Fundus photo. 2228 by 1652 pixels. 50° FOV. Field includes the optic disc and macula.
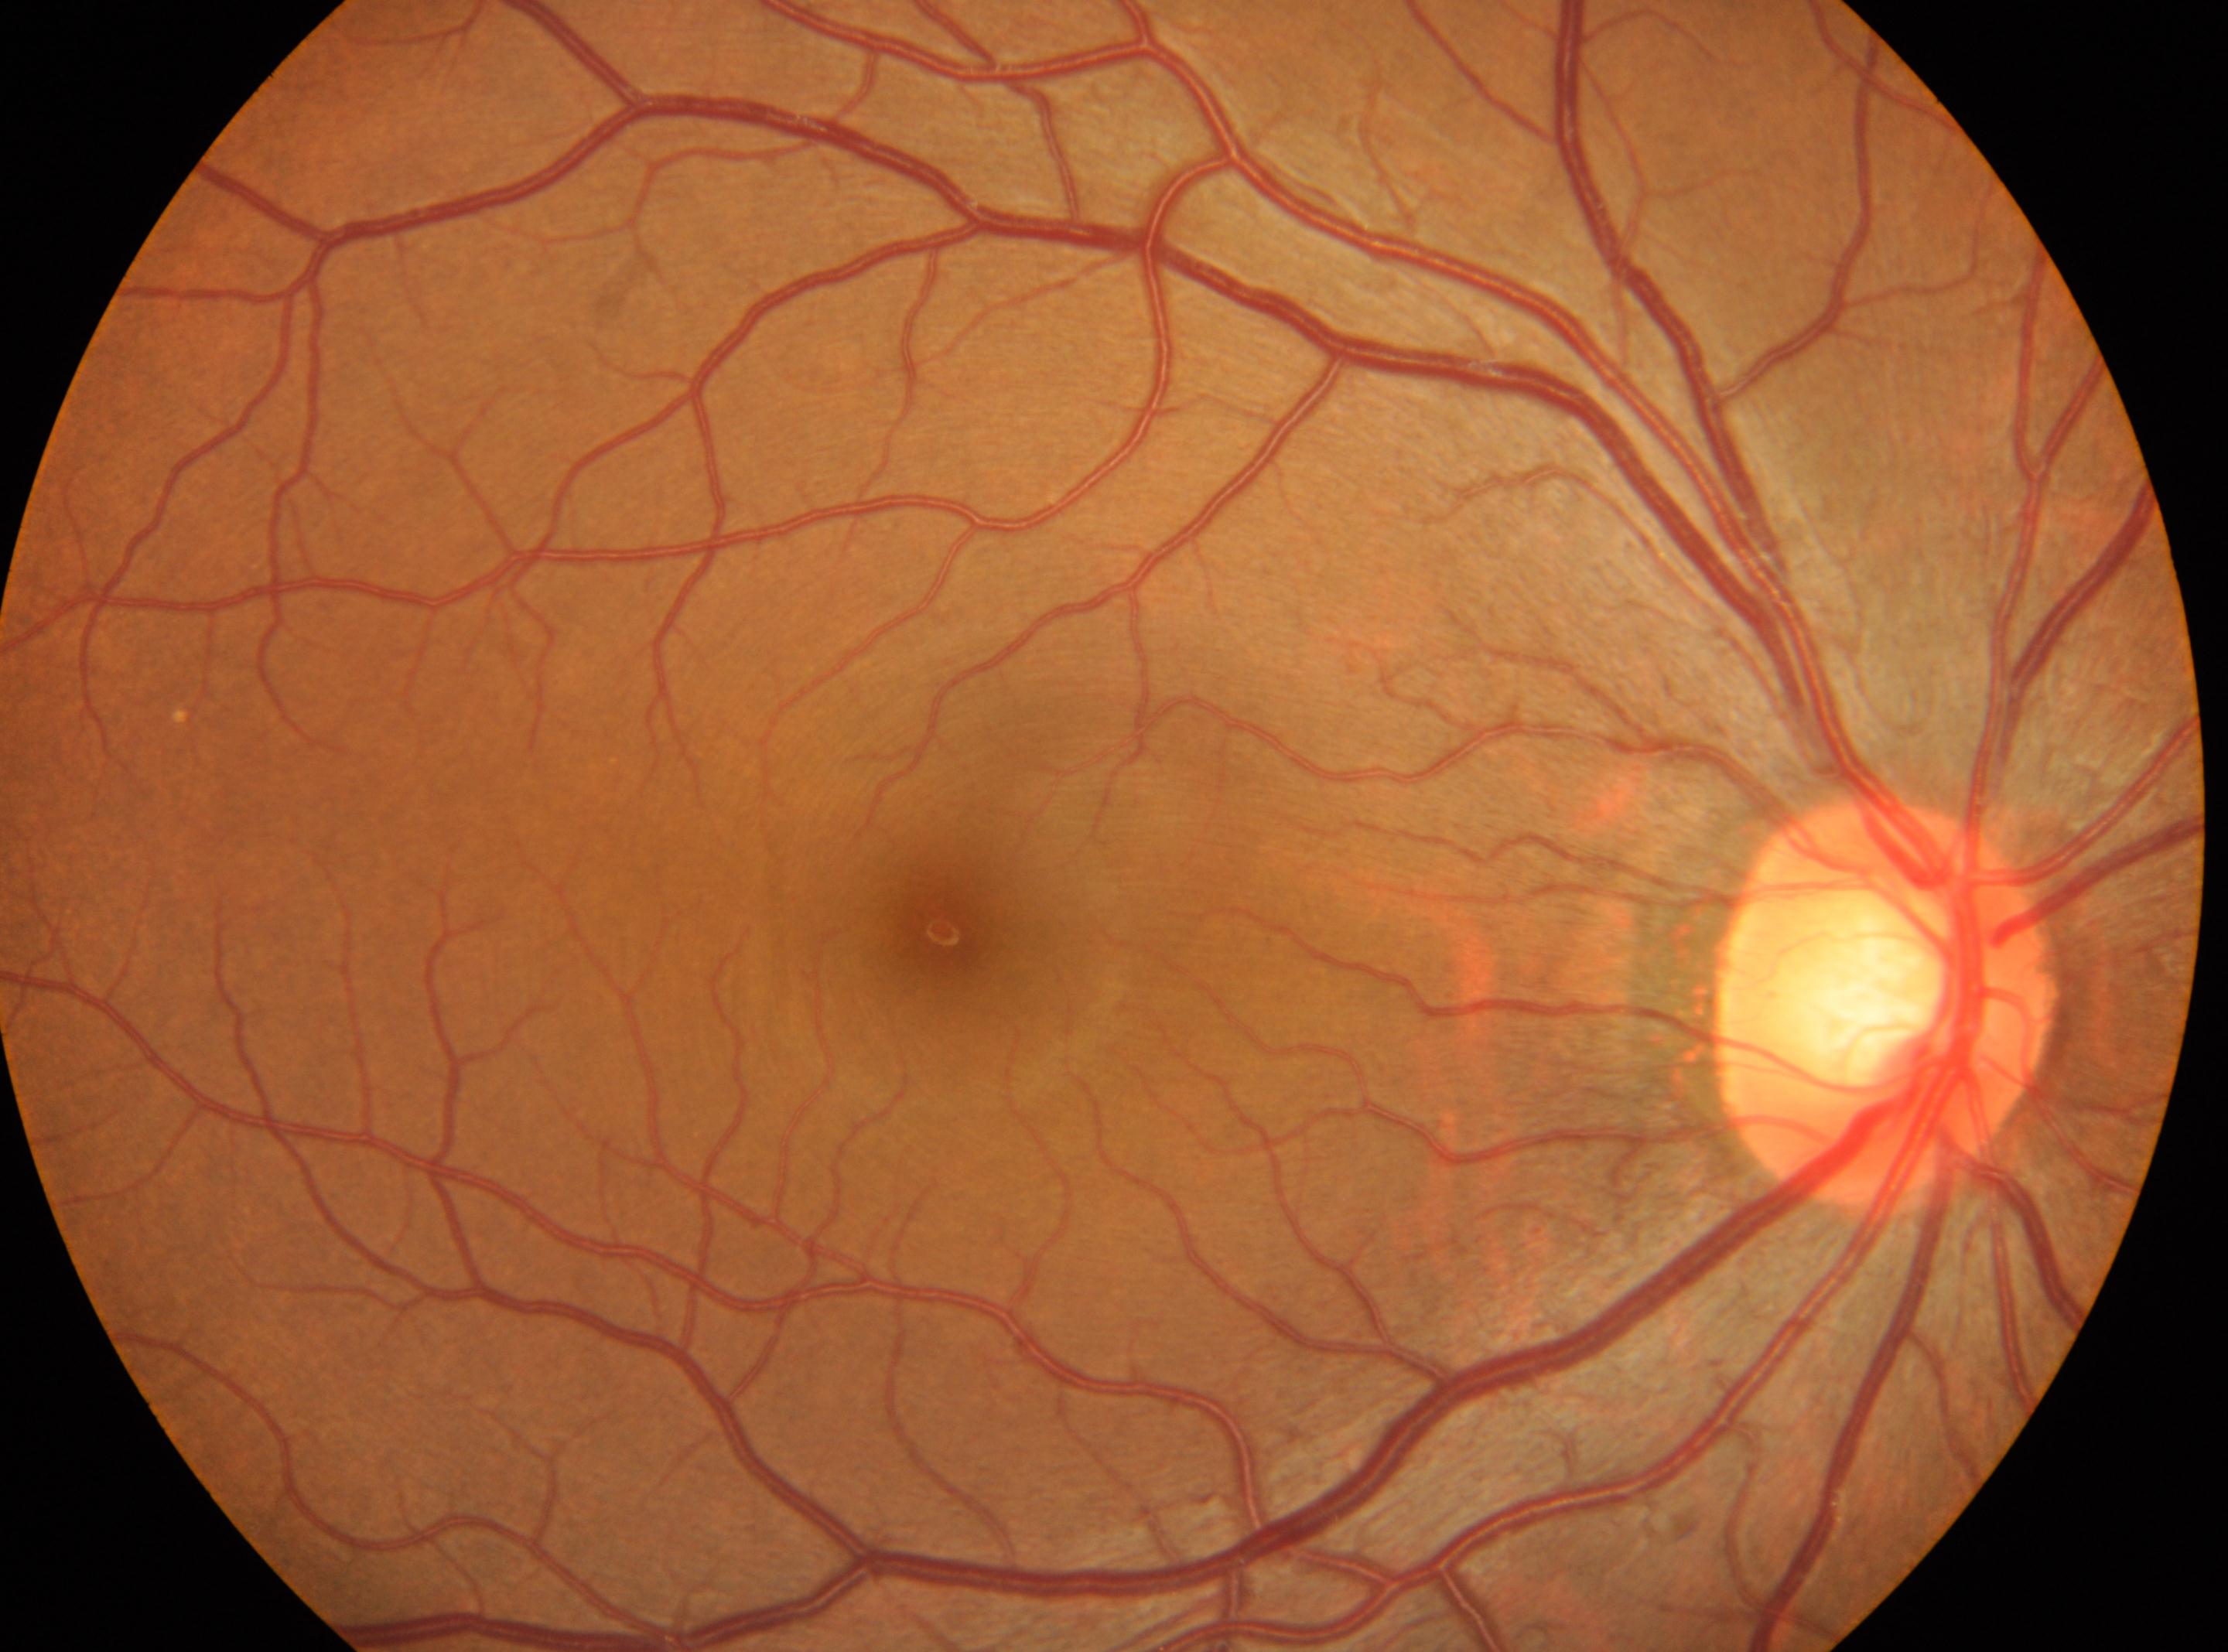
The optic disc center is at 1887px, 1004px. Diabetic retinopathy (DR) is 0/4. No DR findings. Imaged eye: oculus dexter. Macula center located at 941px, 930px.